Wide-field contact fundus photograph of an infant
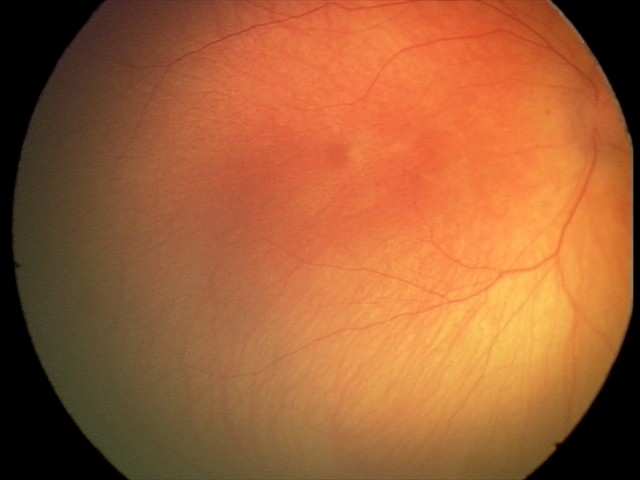 Physiological retinal appearance for postconceptual age.